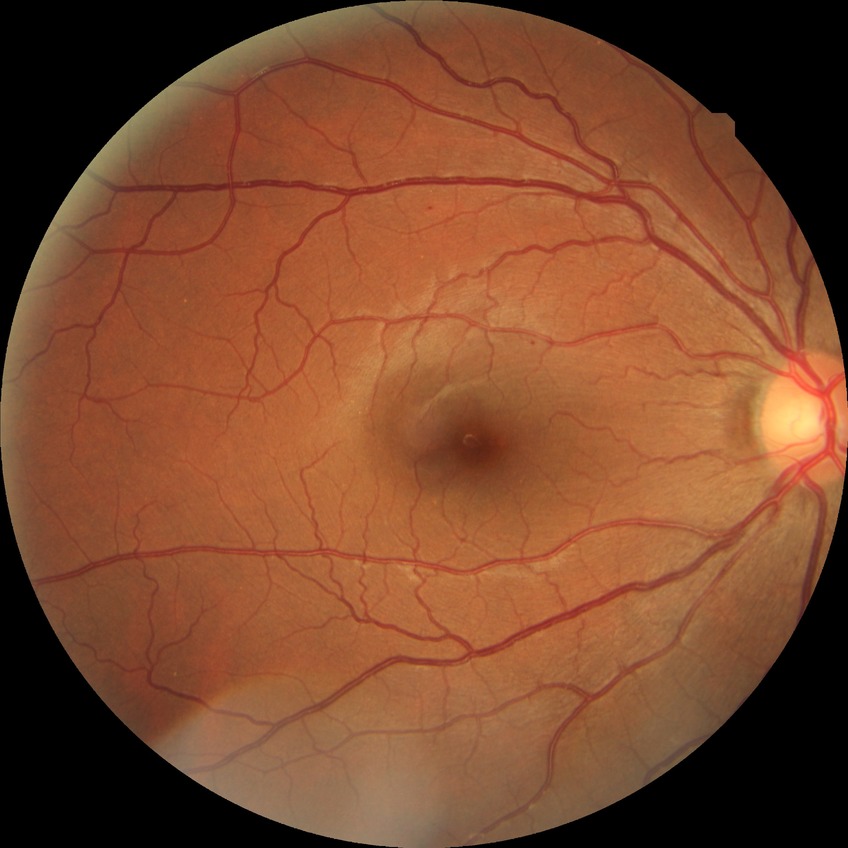 Diabetic retinopathy (DR): SDR (simple diabetic retinopathy).